848x848px
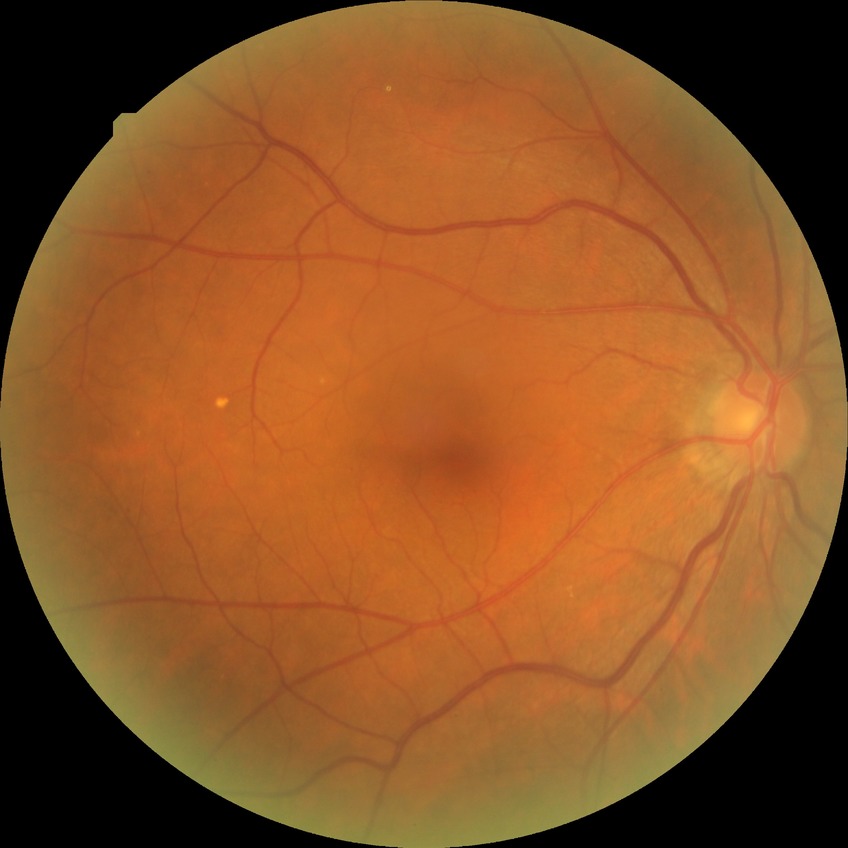

Retinopathy grade is simple diabetic retinopathy.